CFP. 2048x1536px
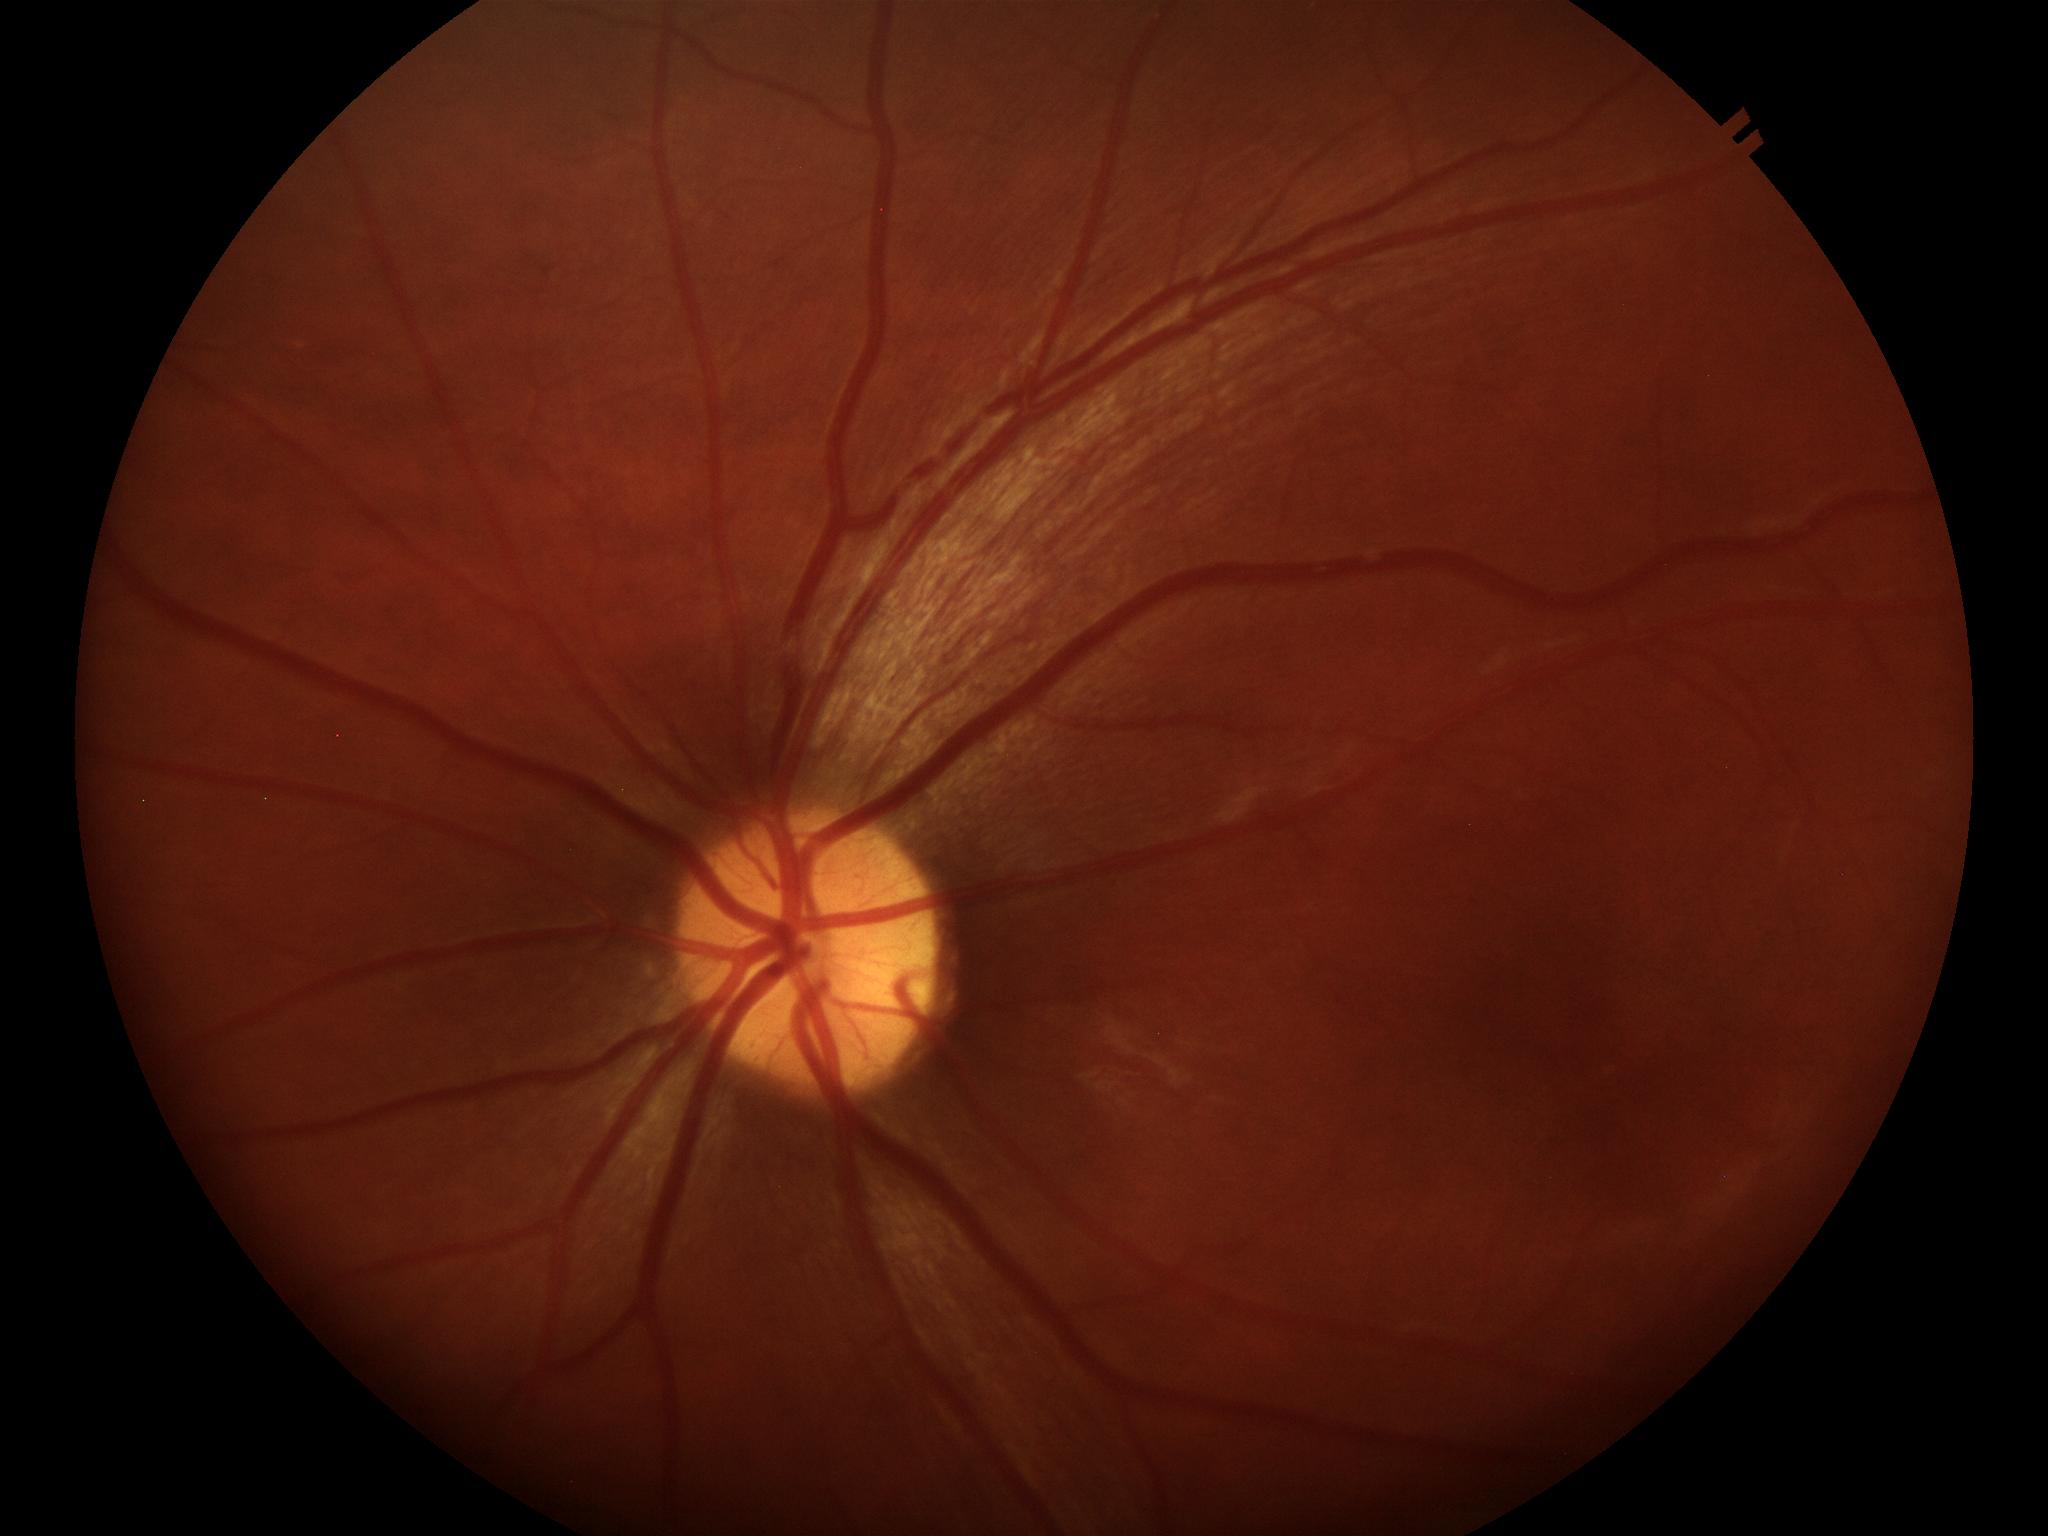 Annotations:
- Glaucoma impression · not suspect
- VCDR · 0.44